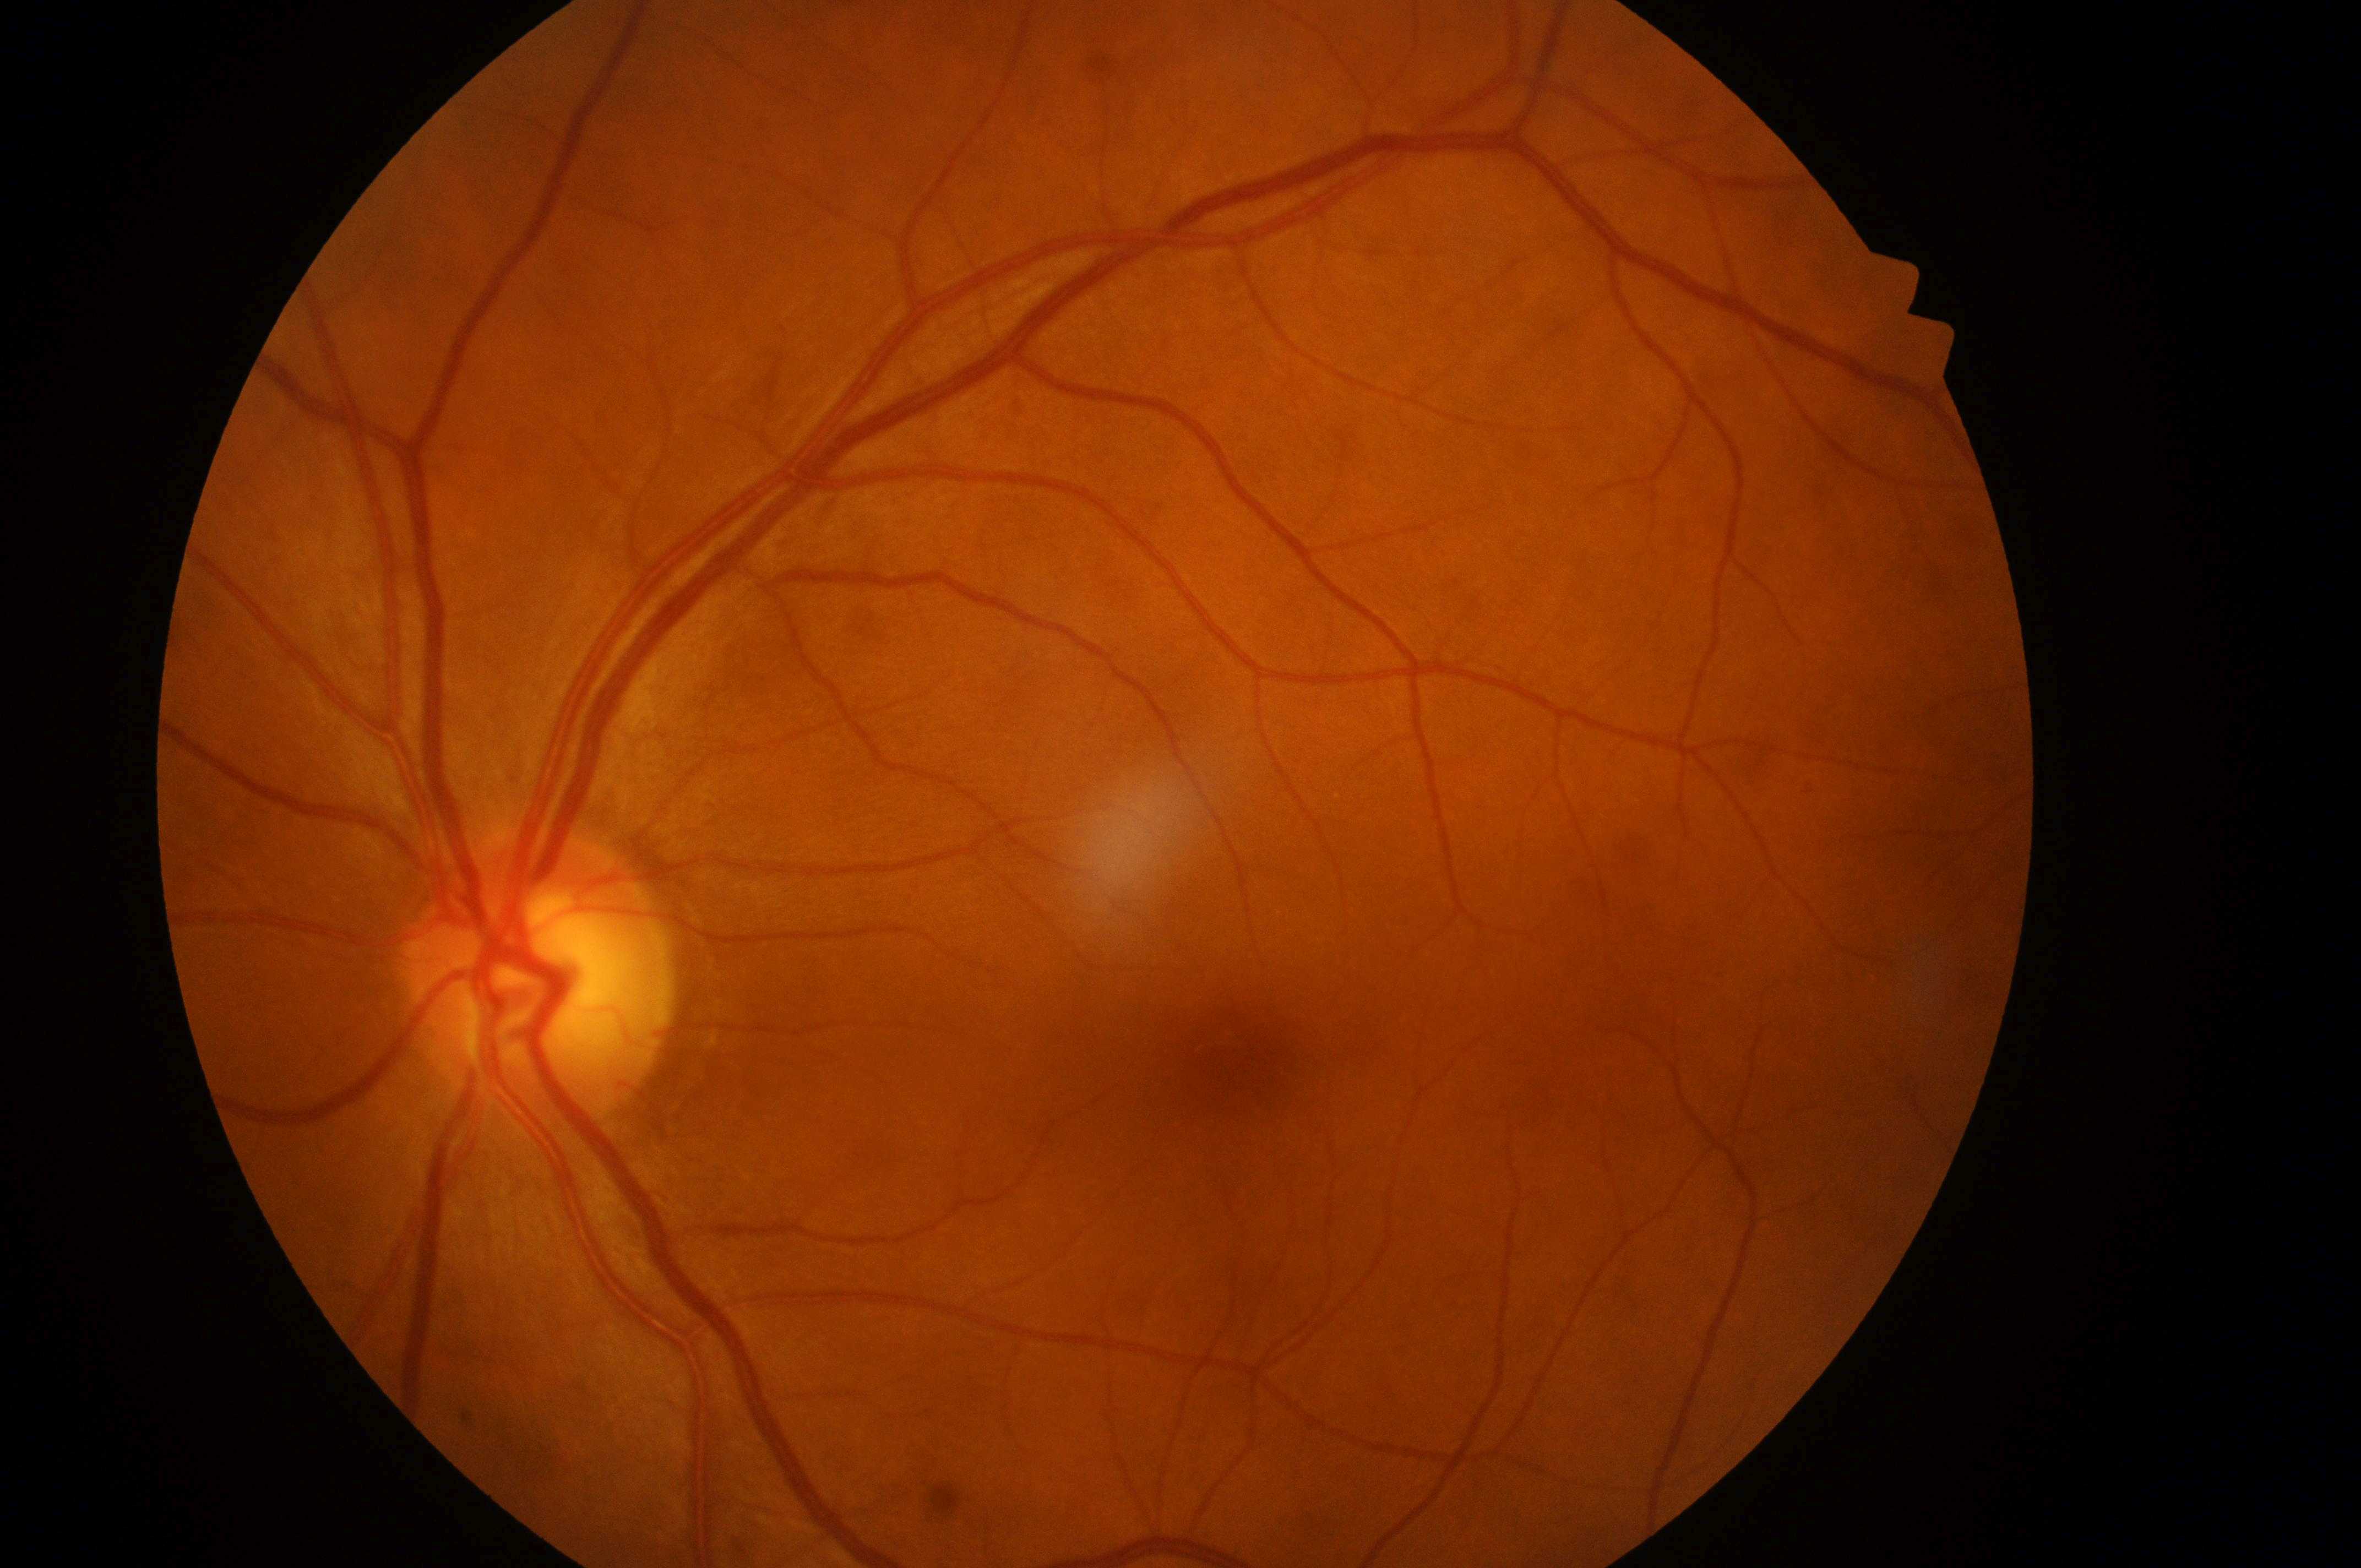

The foveal center is at (x: 1244, y: 1064). The optic disc is at (x: 538, y: 989). DR grade is no apparent retinopathy (0) — no visible signs of diabetic retinopathy. The image shows the oculus sinister. DME is no risk (grade 0) — no apparent hard exudates.